45-degree field of view. CFP. 2352x1568 — 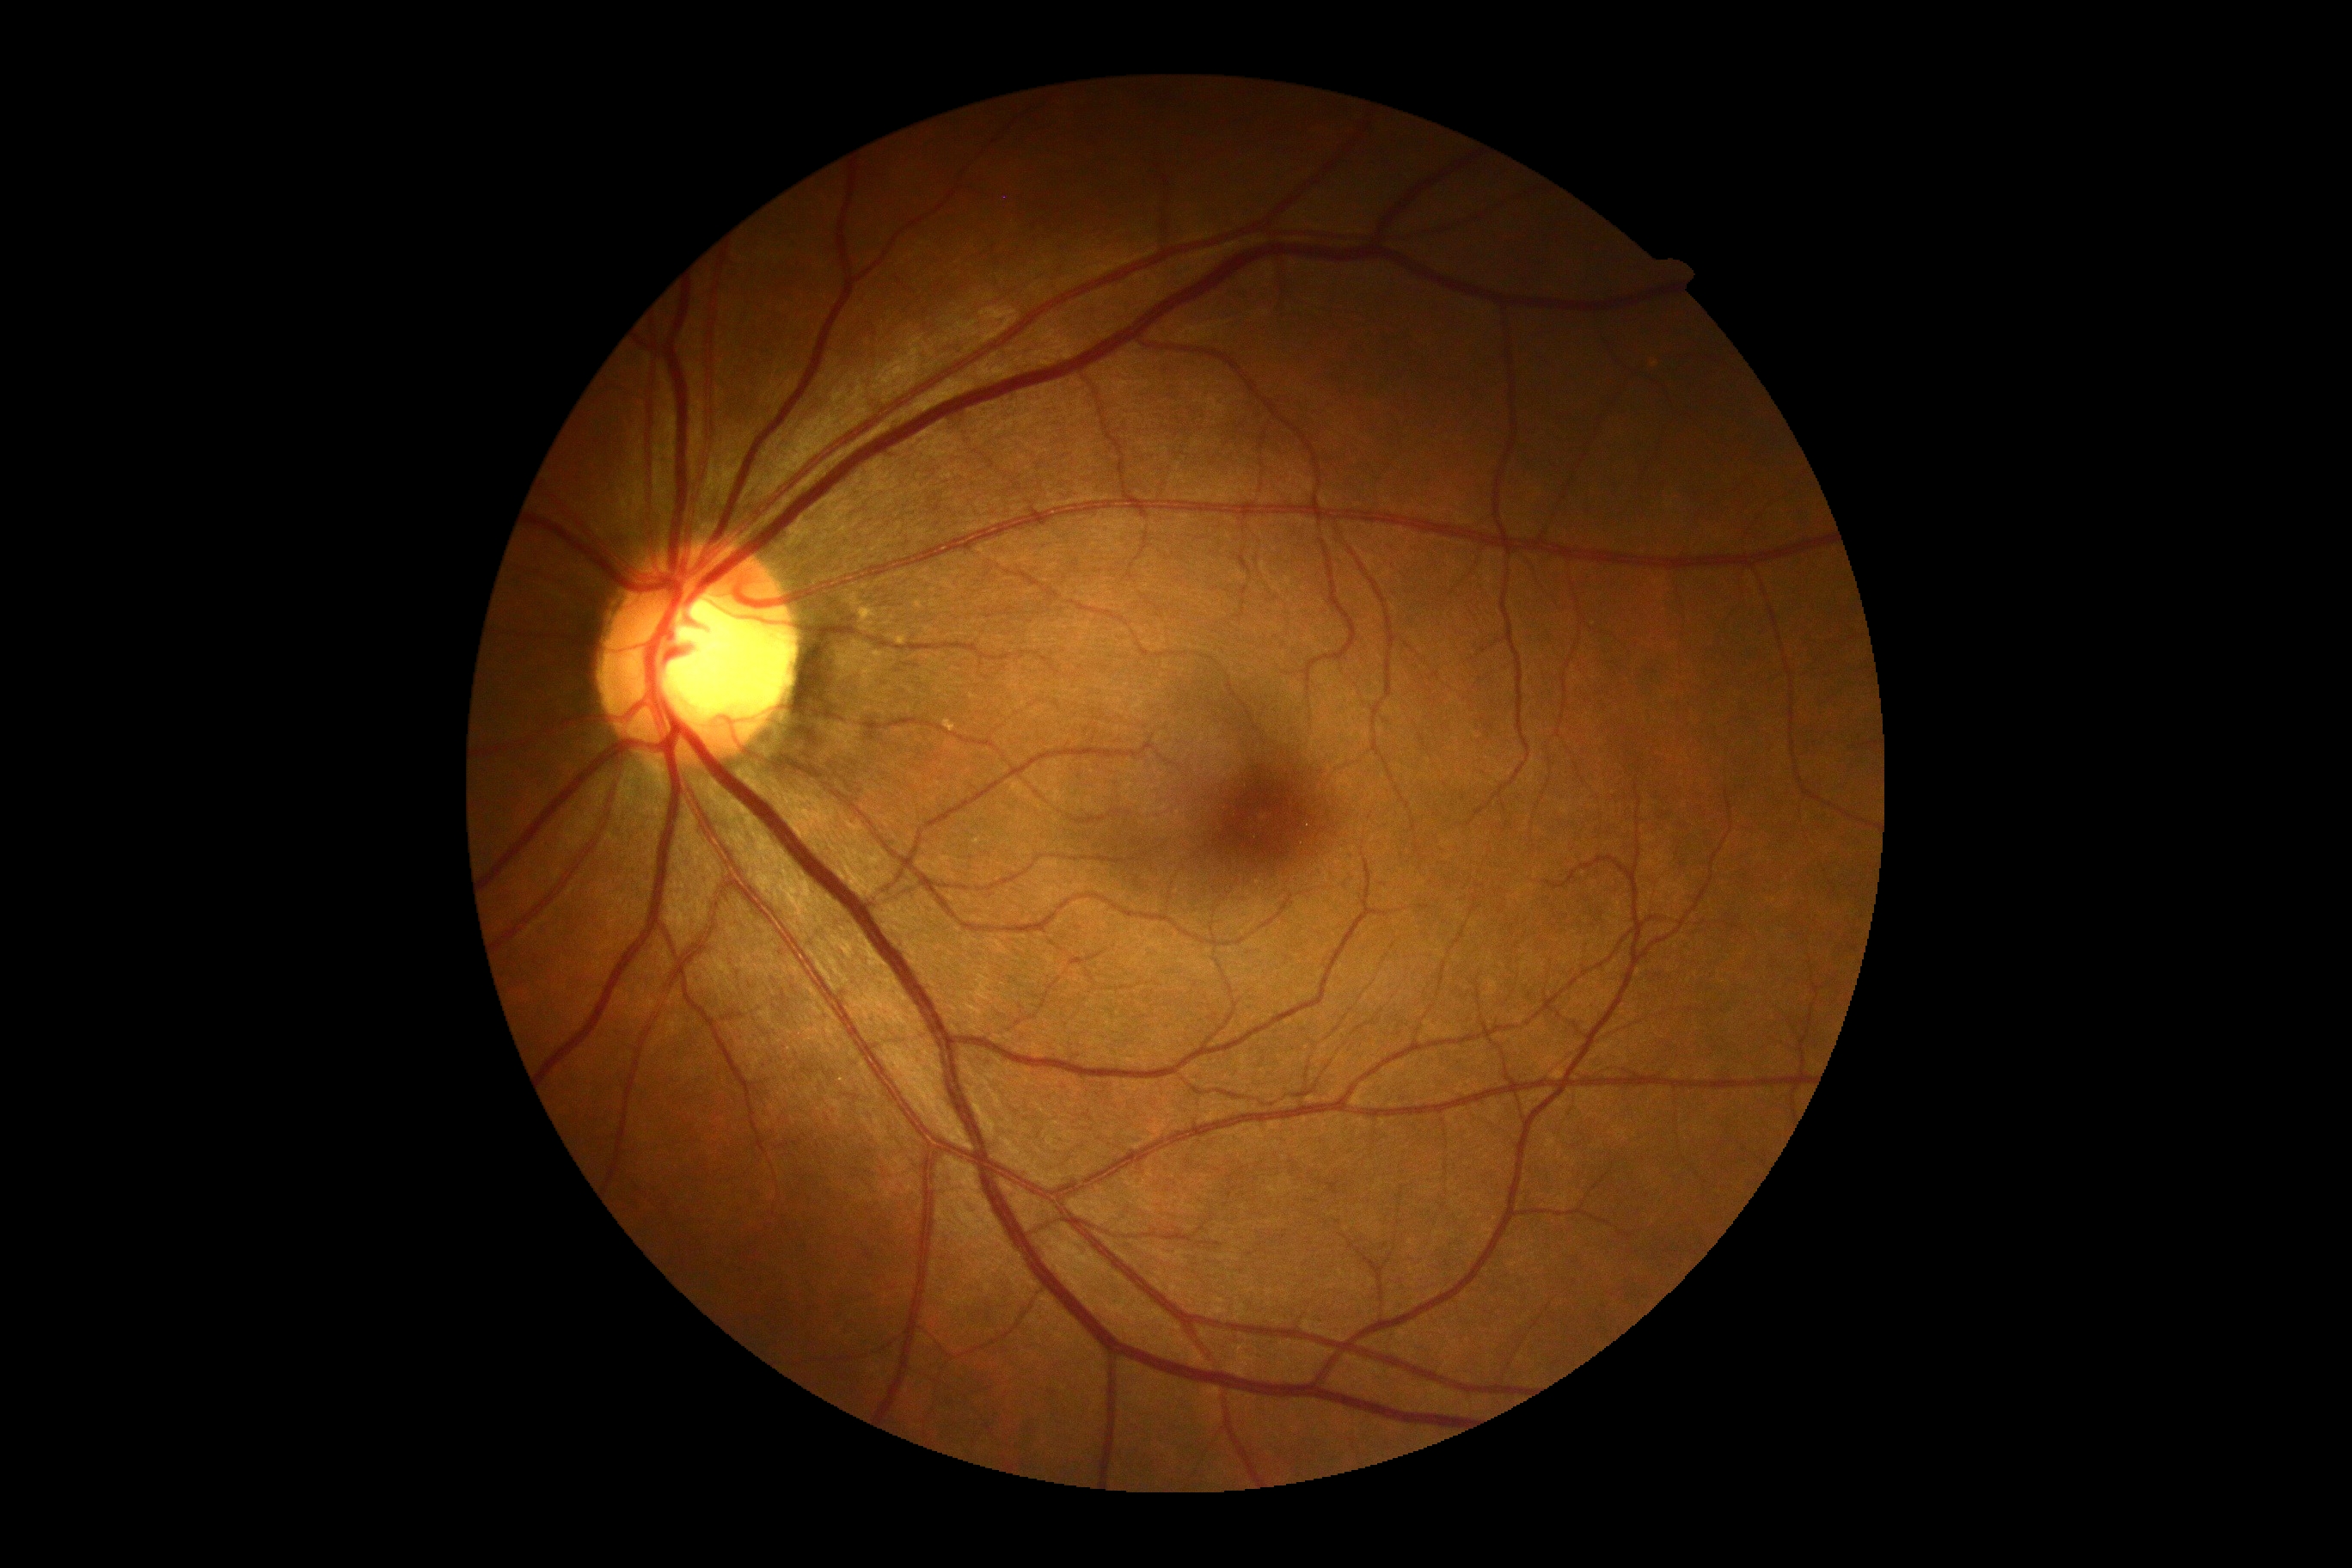
diabetic retinopathy (DR): grade 0 (no apparent retinopathy).